45-degree field of view; 848 x 848 pixels:
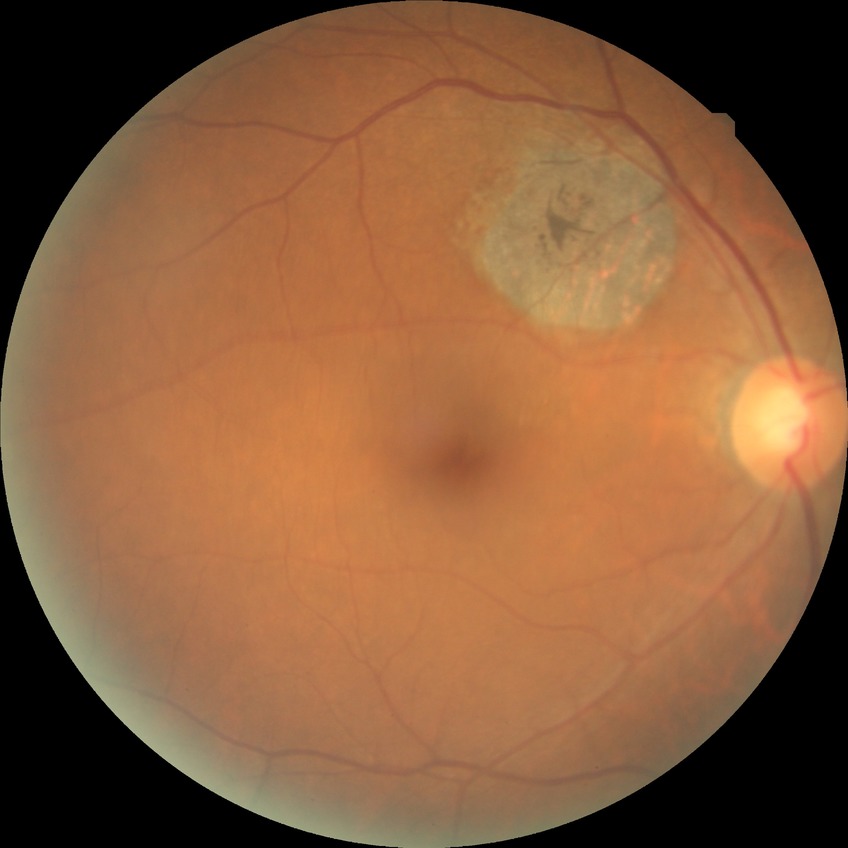 Diabetic retinopathy (DR) is NDR (no diabetic retinopathy).